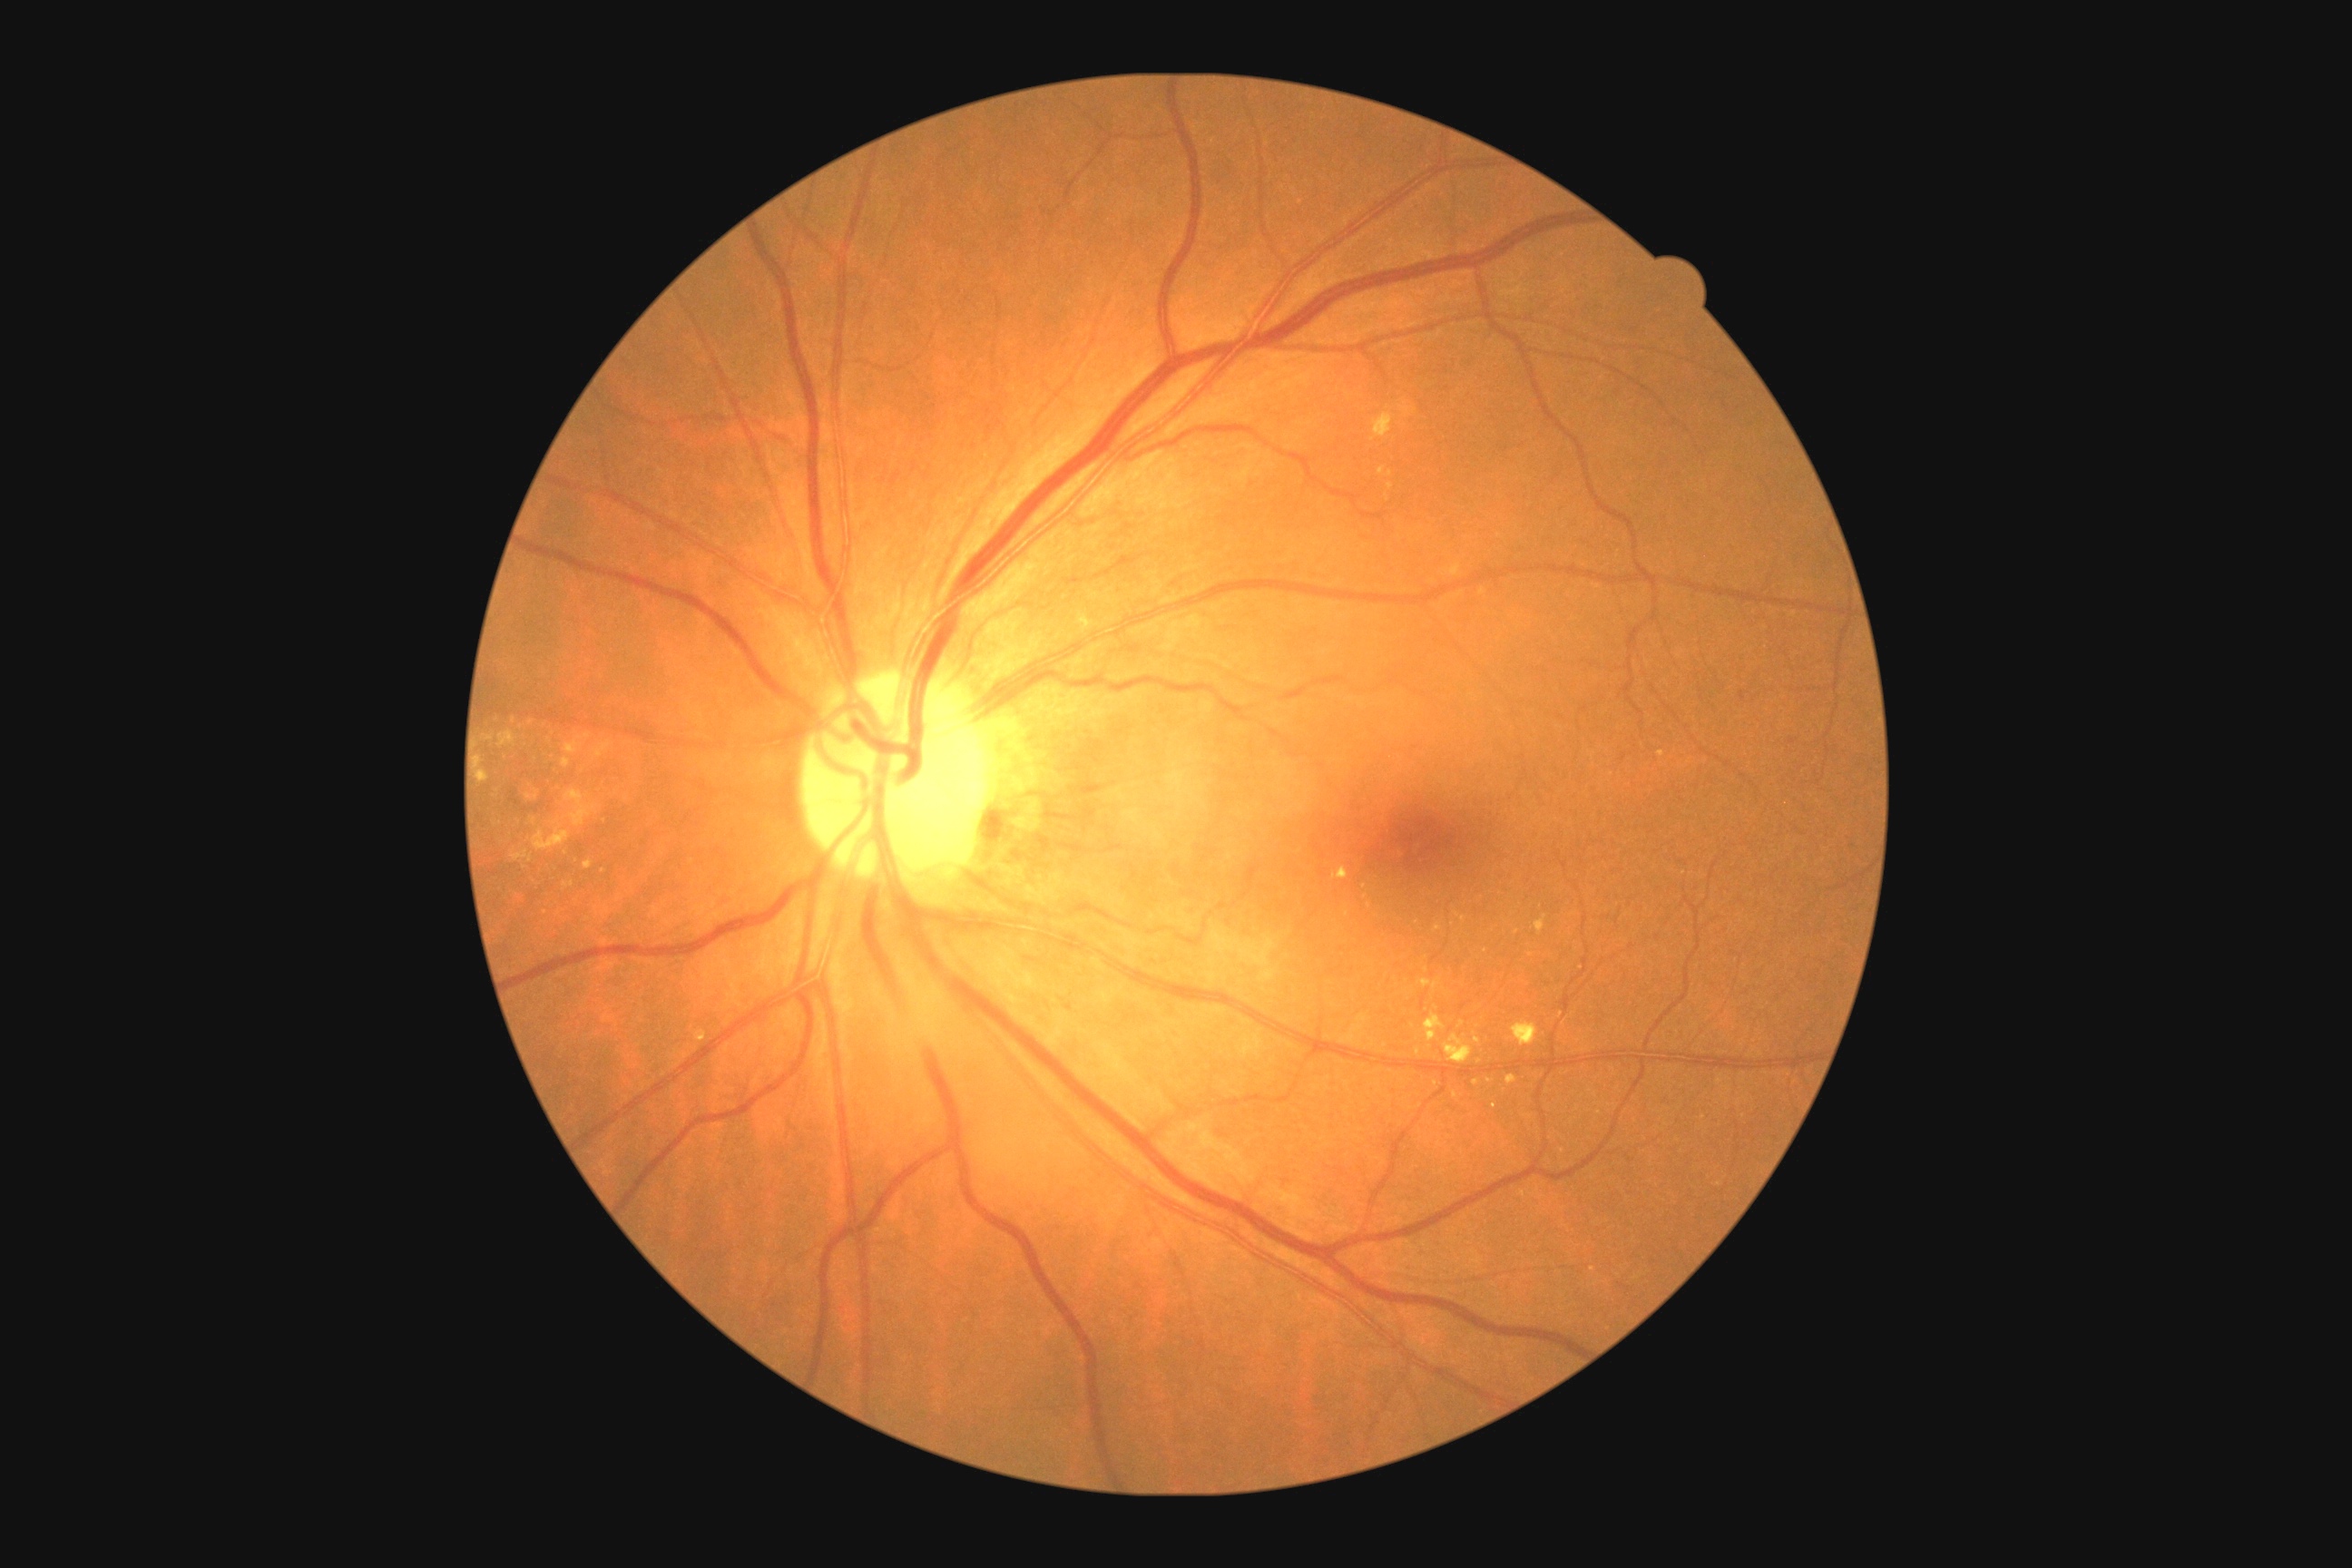

<lesions partial="true">
  <dr_grade>2</dr_grade>
  <se />
  <ex partial="true">{"x1": 1505, "y1": 1075, "x2": 1518, "y2": 1084} | {"x1": 1511, "y1": 1021, "x2": 1538, "y2": 1046} | {"x1": 565, "y1": 734, "x2": 591, "y2": 754} | {"x1": 564, "y1": 881, "x2": 574, "y2": 888} | {"x1": 1536, "y1": 916, "x2": 1547, "y2": 936} | {"x1": 1378, "y1": 467, "x2": 1393, "y2": 478} | {"x1": 565, "y1": 790, "x2": 598, "y2": 827} | {"x1": 498, "y1": 730, "x2": 516, "y2": 747}</ex>
  <ex_small_approx>531:723 | 1531:955 | 1438:928 | 1364:887 | 1387:498 | 1458:915 | 587:919 | 1476:1083 | 1517:932 | 1436:1085 | 1346:913</ex_small_approx>
  <he>{"x1": 1146, "y1": 1226, "x2": 1166, "y2": 1237} | {"x1": 1790, "y1": 740, "x2": 1798, "y2": 745} | {"x1": 1740, "y1": 692, "x2": 1745, "y2": 701}</he>
  <he_small_approx>1624:757</he_small_approx>
  <ma />
</lesions>